Without pupil dilation · NIDEK AFC-230 — 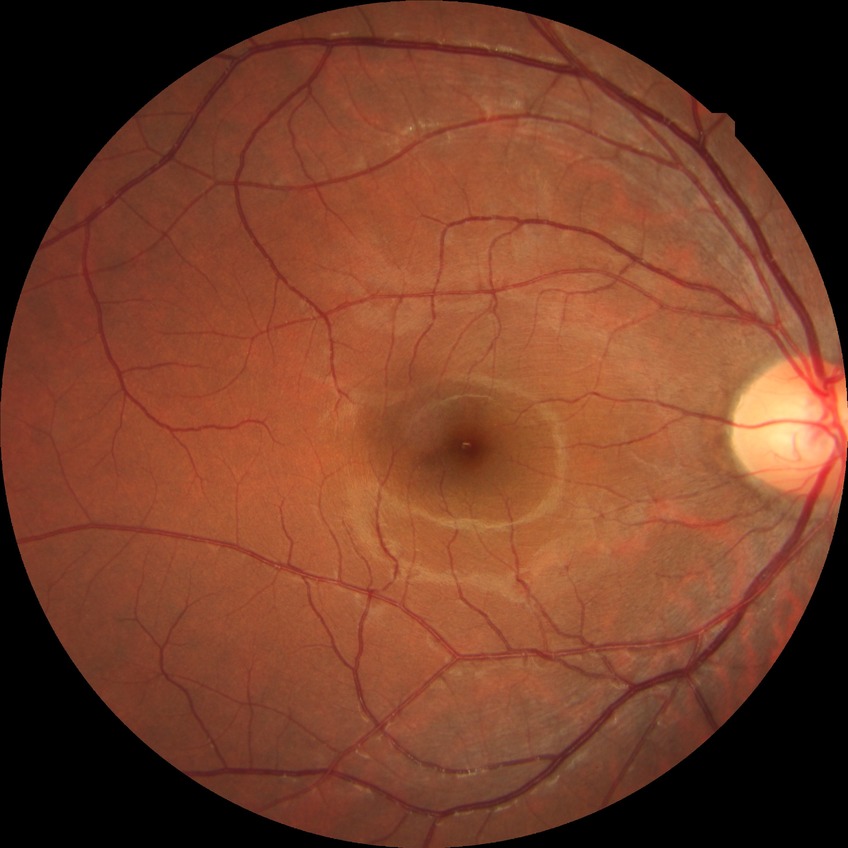
Davis grade: NDR